Wide-field fundus photograph from neonatal ROP screening. 1440x1080px
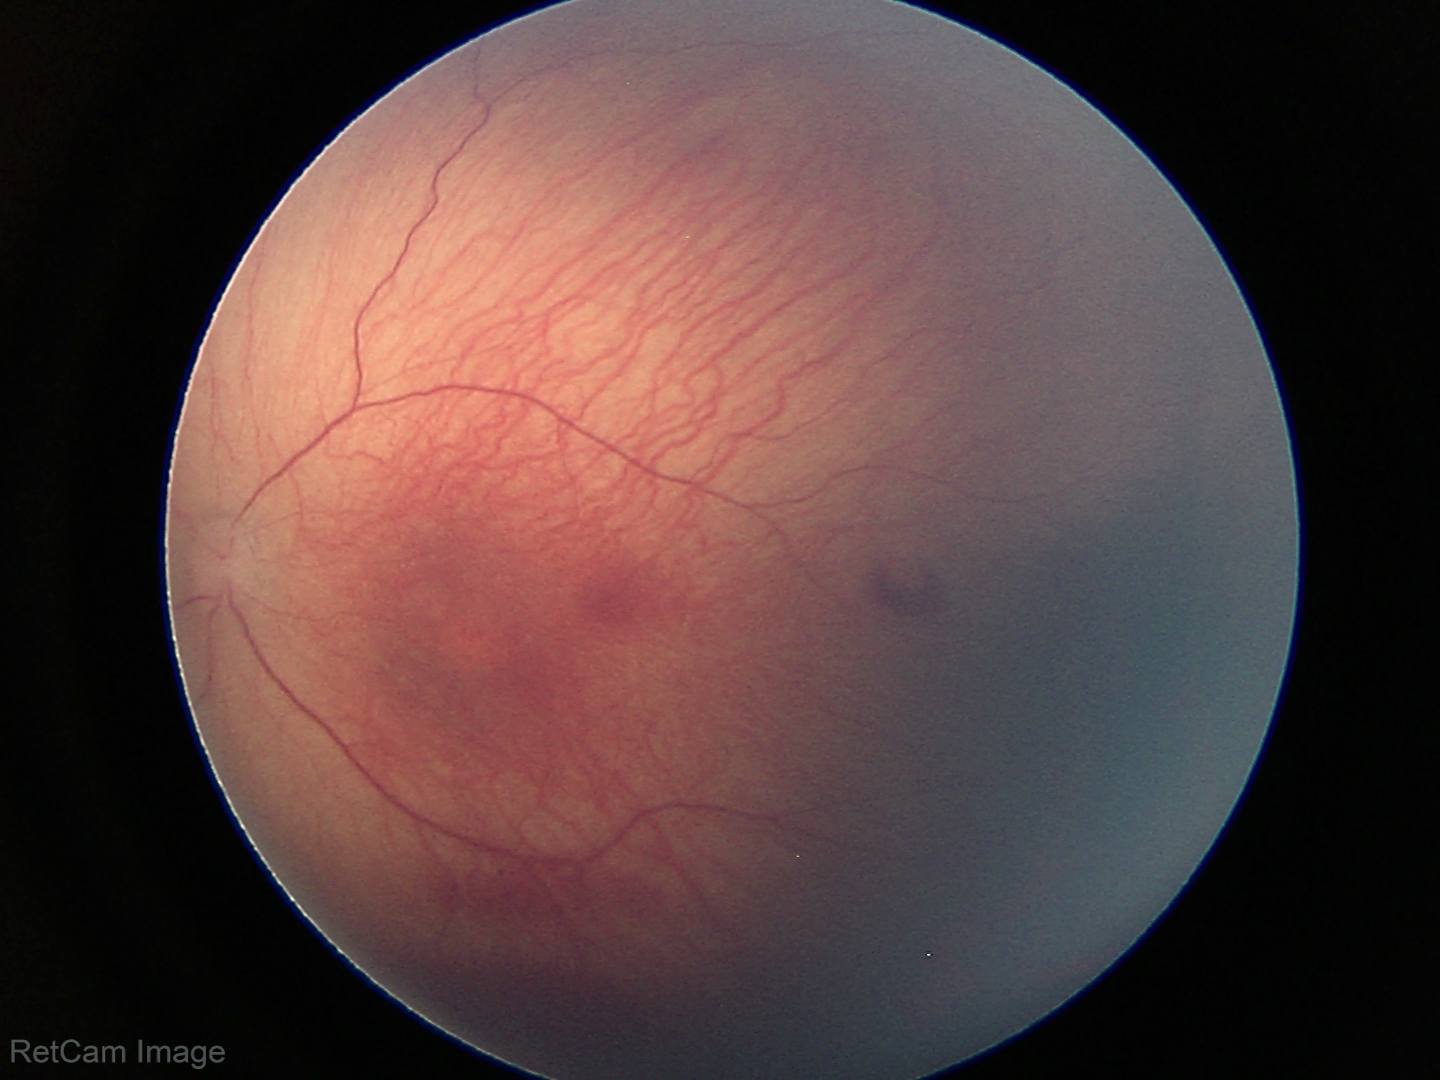
Series diagnosed as retinopathy of prematurity (ROP) stage 1. Plus disease absent.